Nidek AFC-330, 240x240:
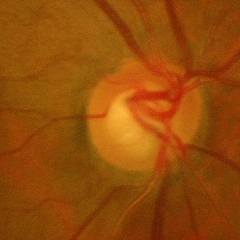

Assessment: advanced glaucomatous optic neuropathy.